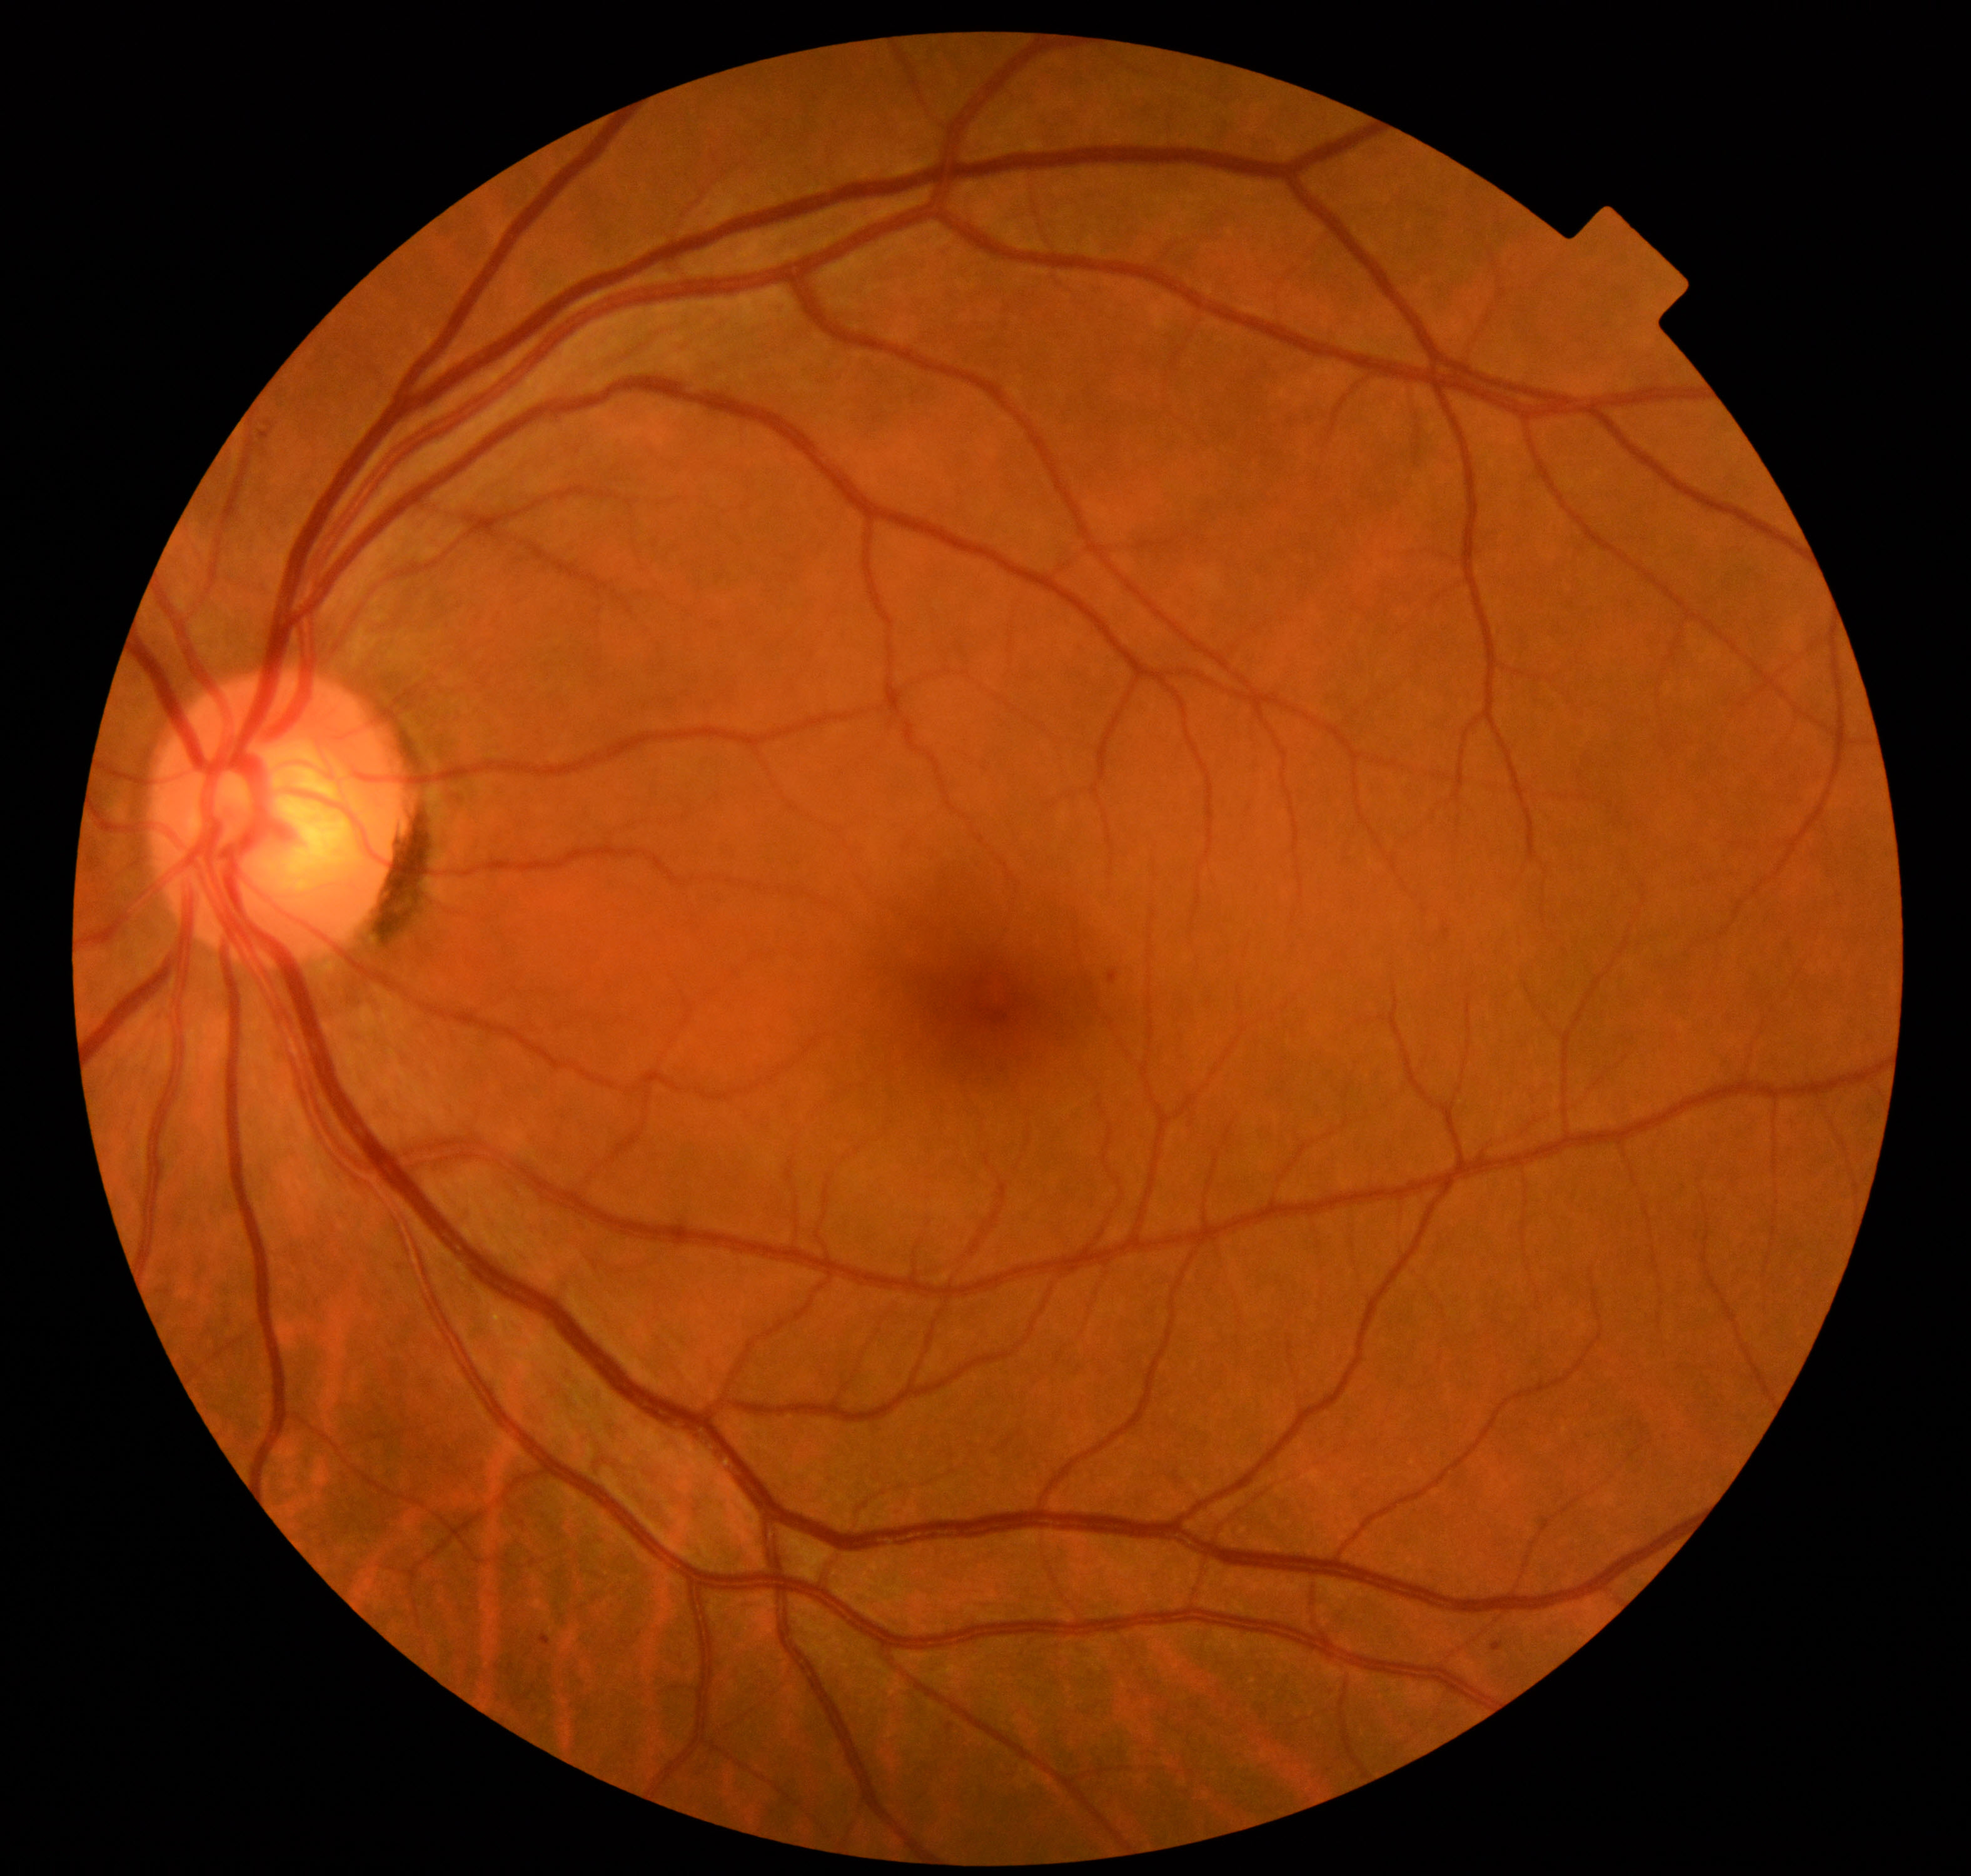
Findings: mild non-proliferative diabetic retinopathy.